Wide-field contact fundus photograph of an infant.
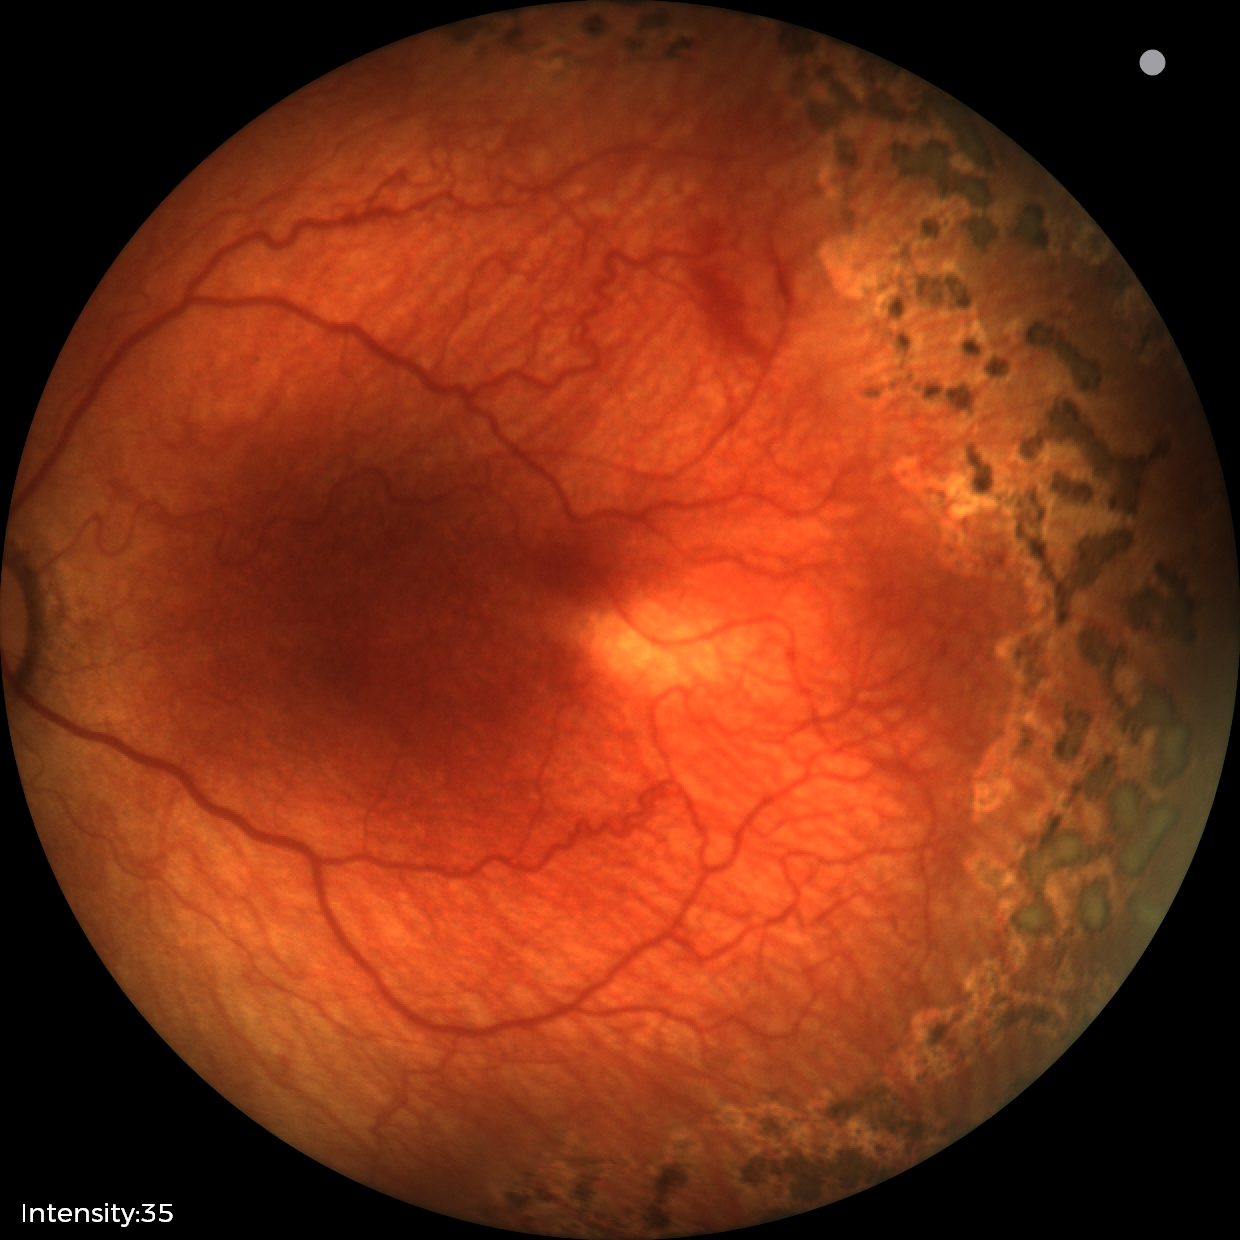
Screening: retinopathy of prematurity (ROP) stage 1 | plus disease.